Davis DR grading:
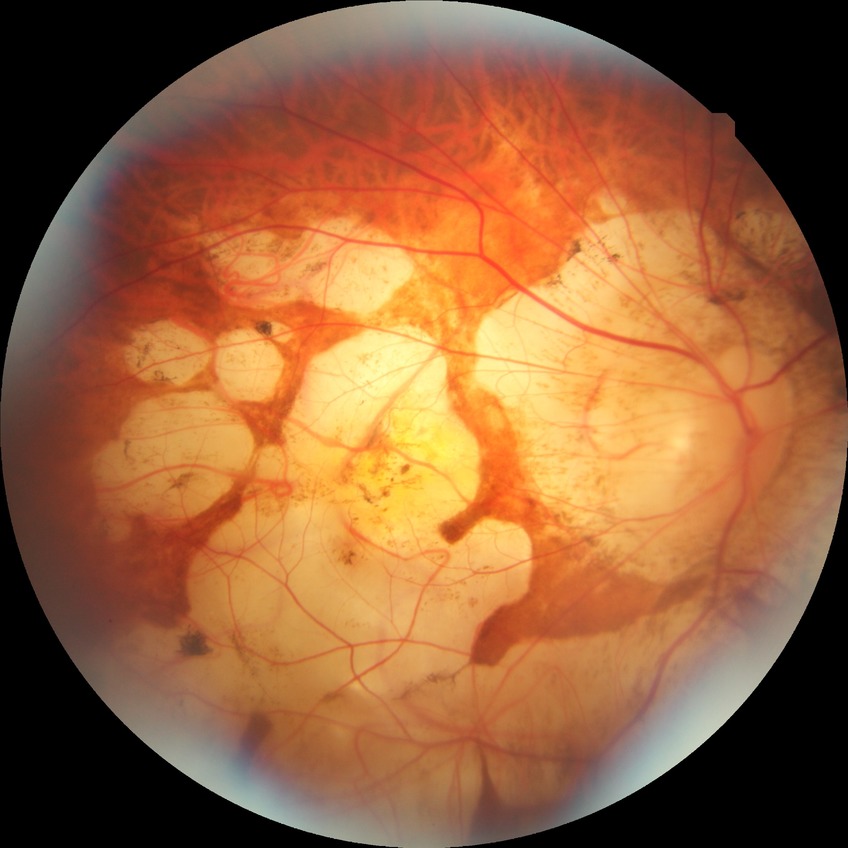

{
  "davis_grade": "no diabetic retinopathy"
}